Retinal fundus photograph — 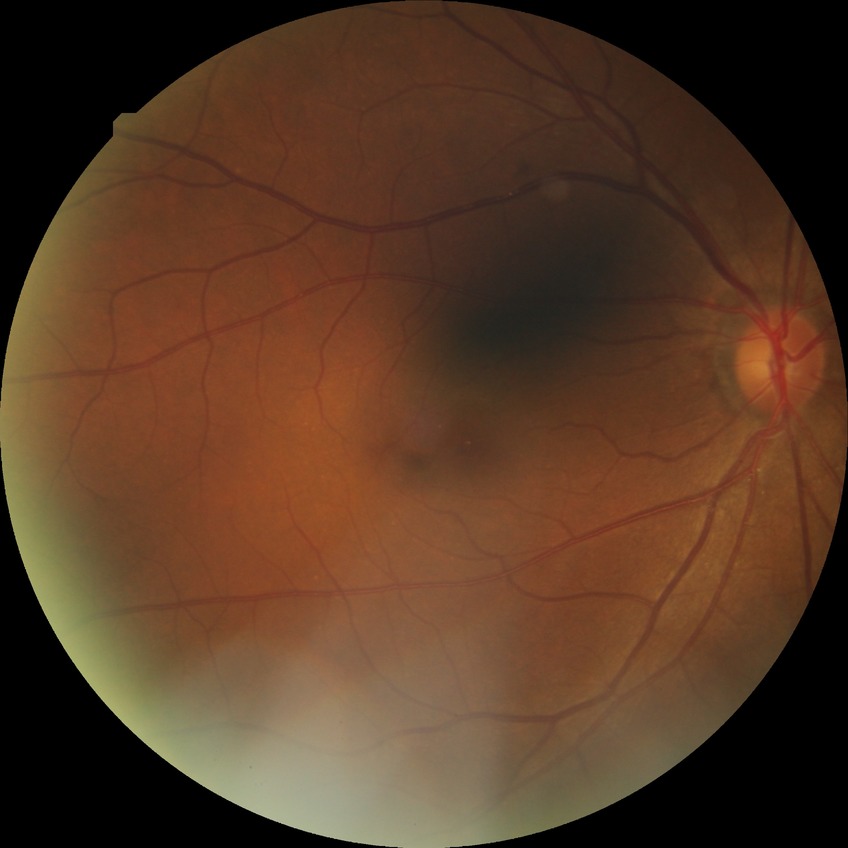 diabetic retinopathy (DR) = no diabetic retinopathy (NDR)